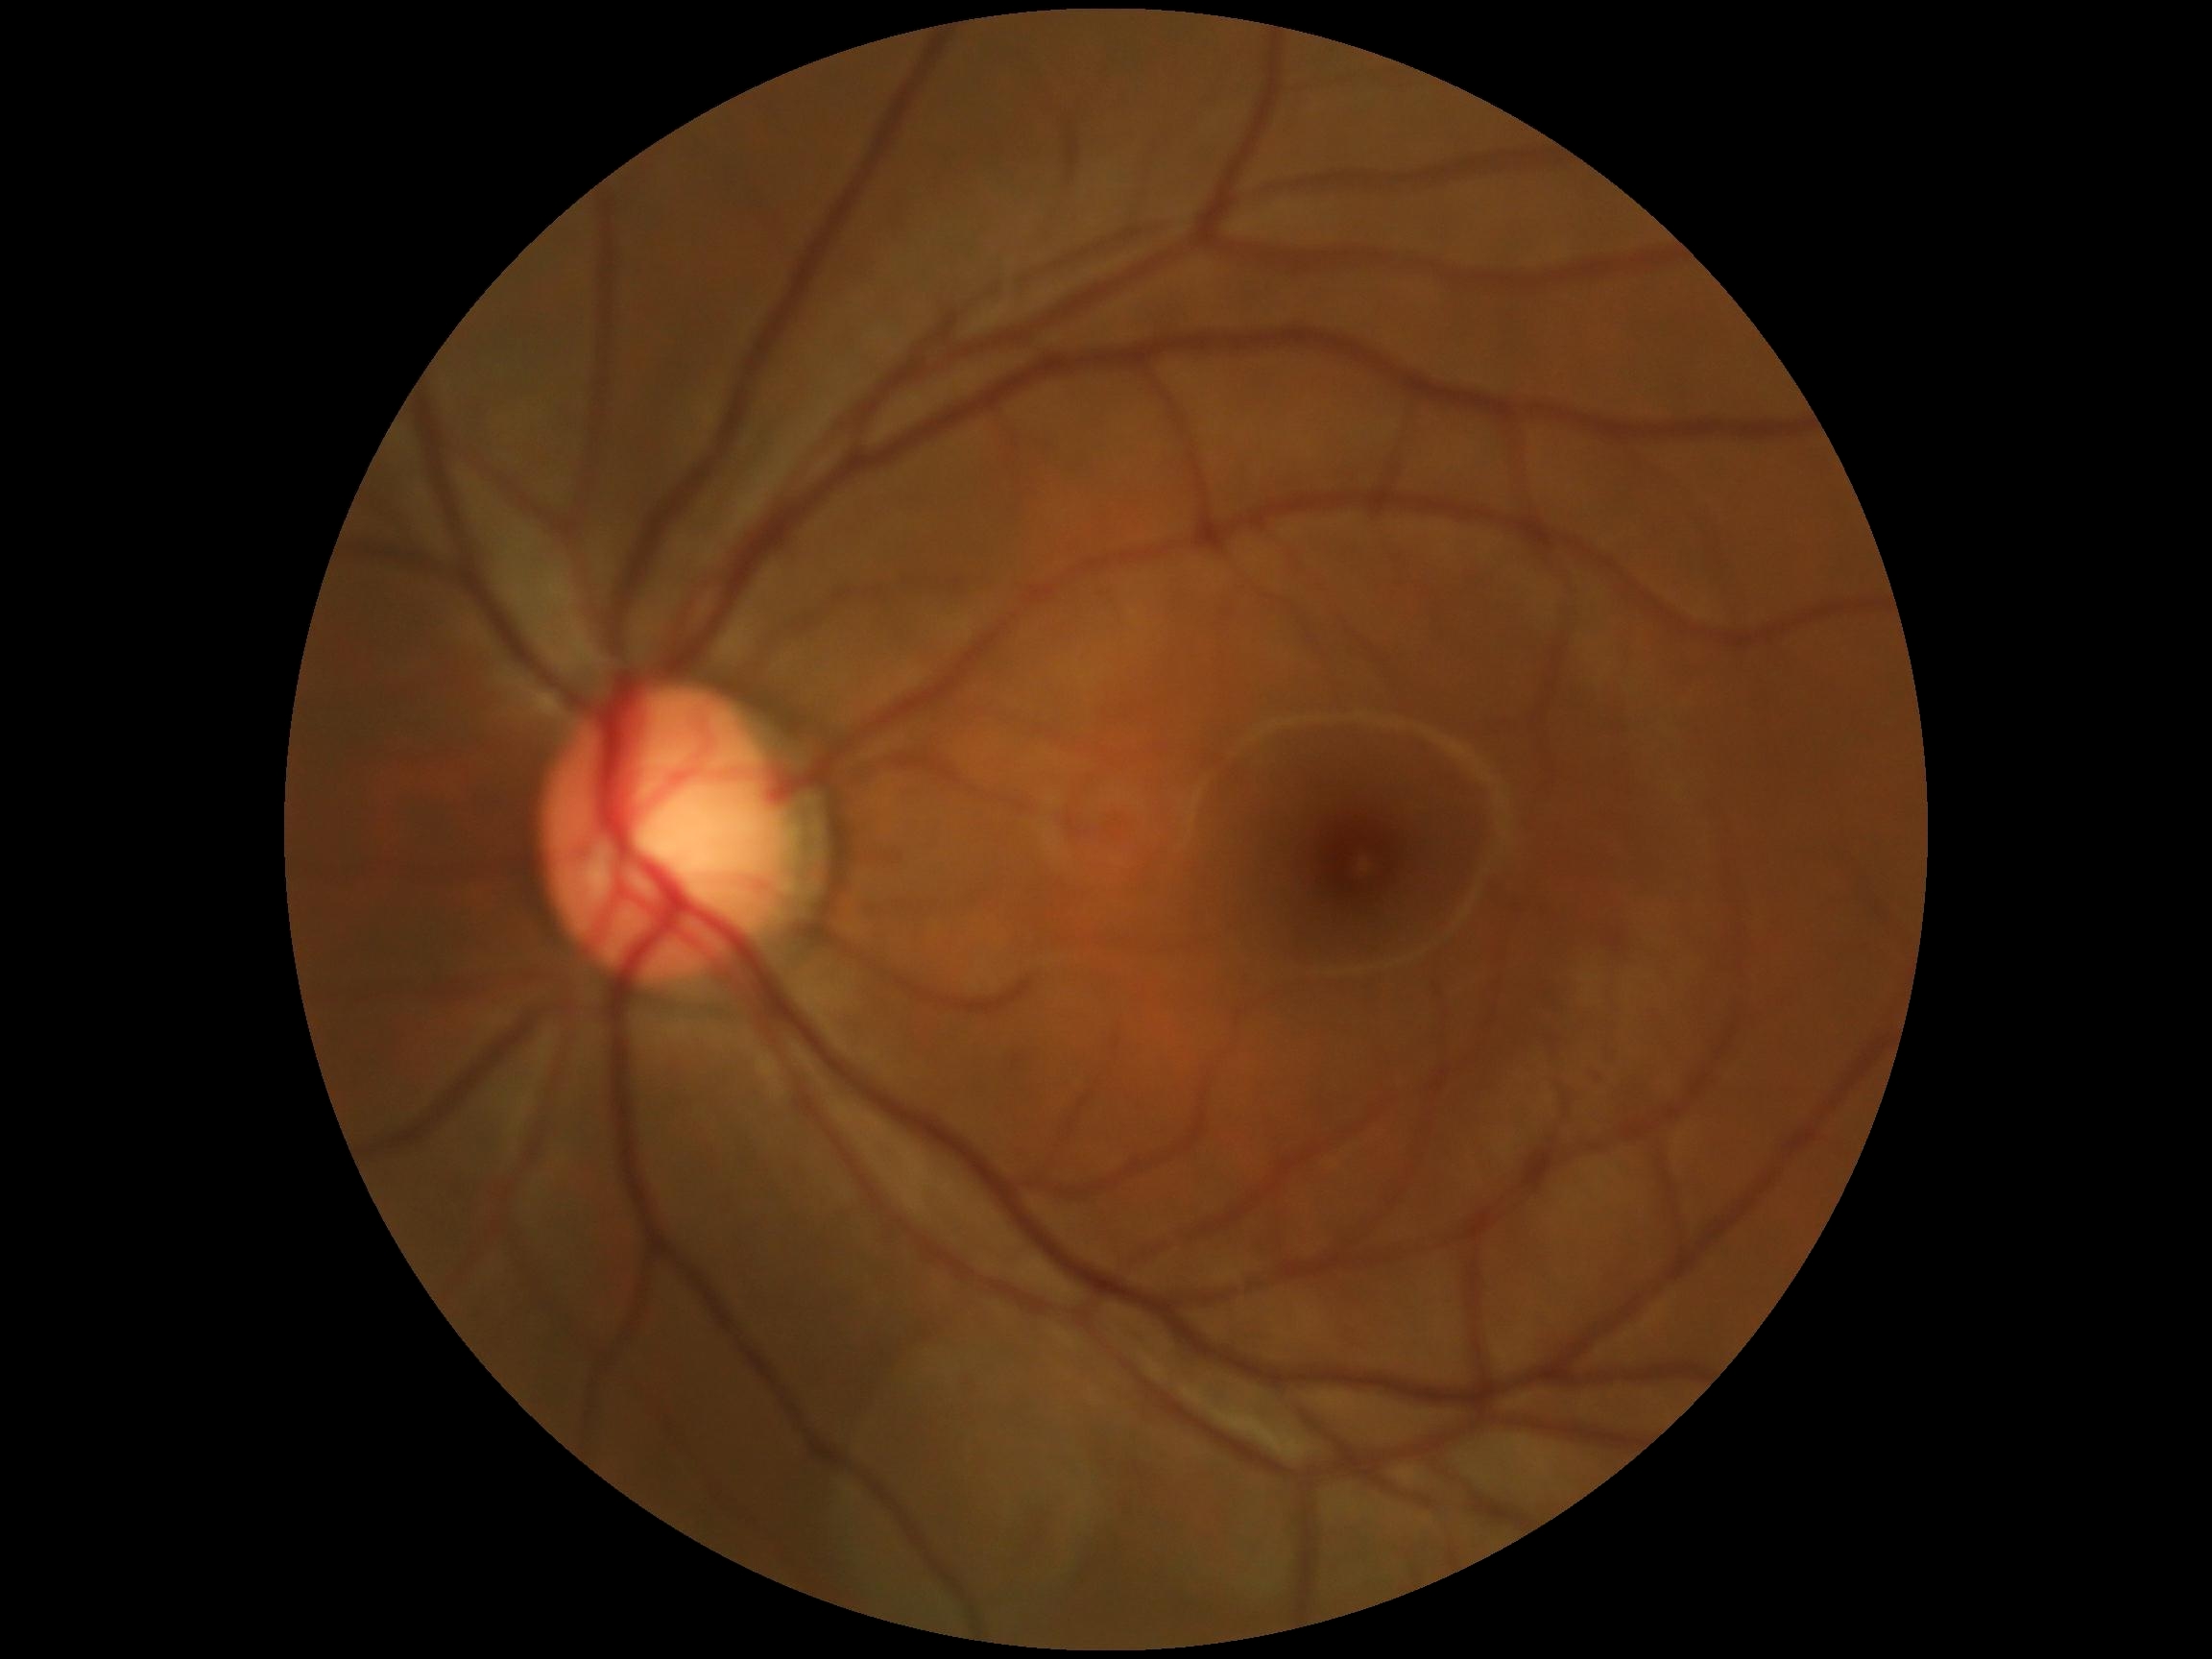 DR grade: 0.